50° field of view. Centered on the macula. Camera: Kowa VX-10α. Pupil-dilated. CFP: 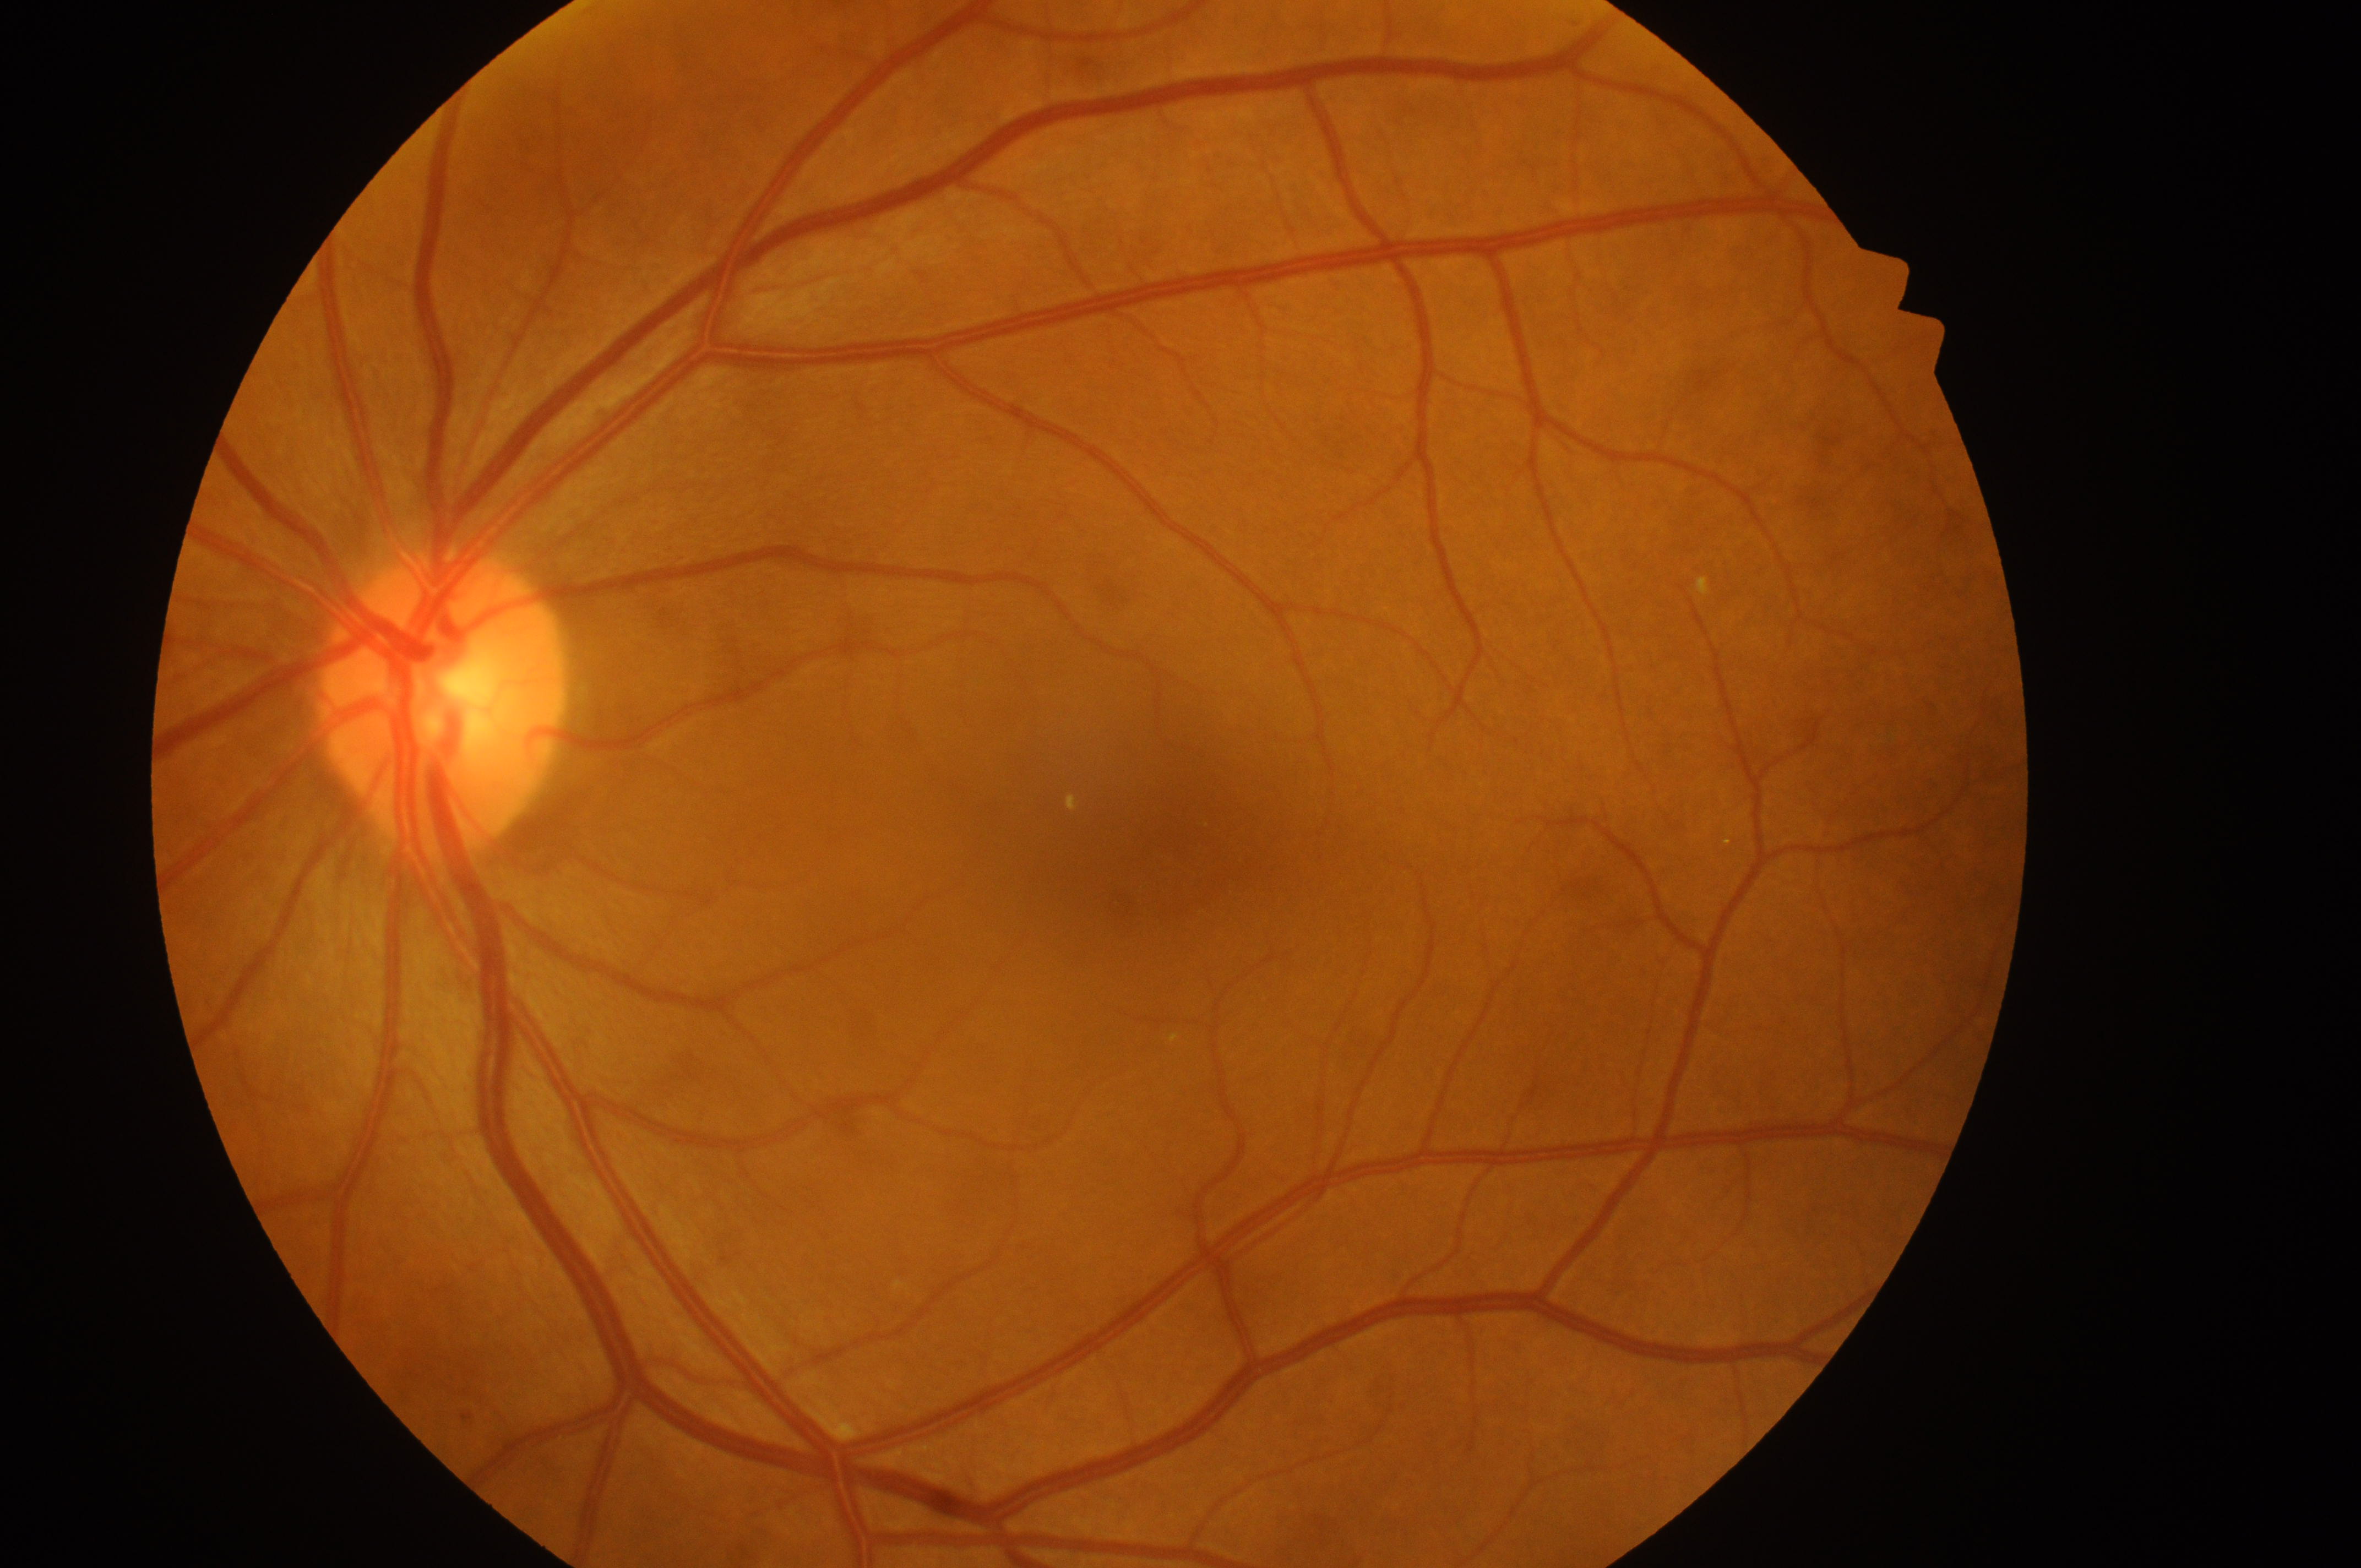 {
  "fovea": "1182, 856",
  "dr_grade": "0 (no apparent retinopathy)",
  "eye": "OS",
  "dme_grade": "0 (no risk)",
  "optic_disc": "437, 707"
}